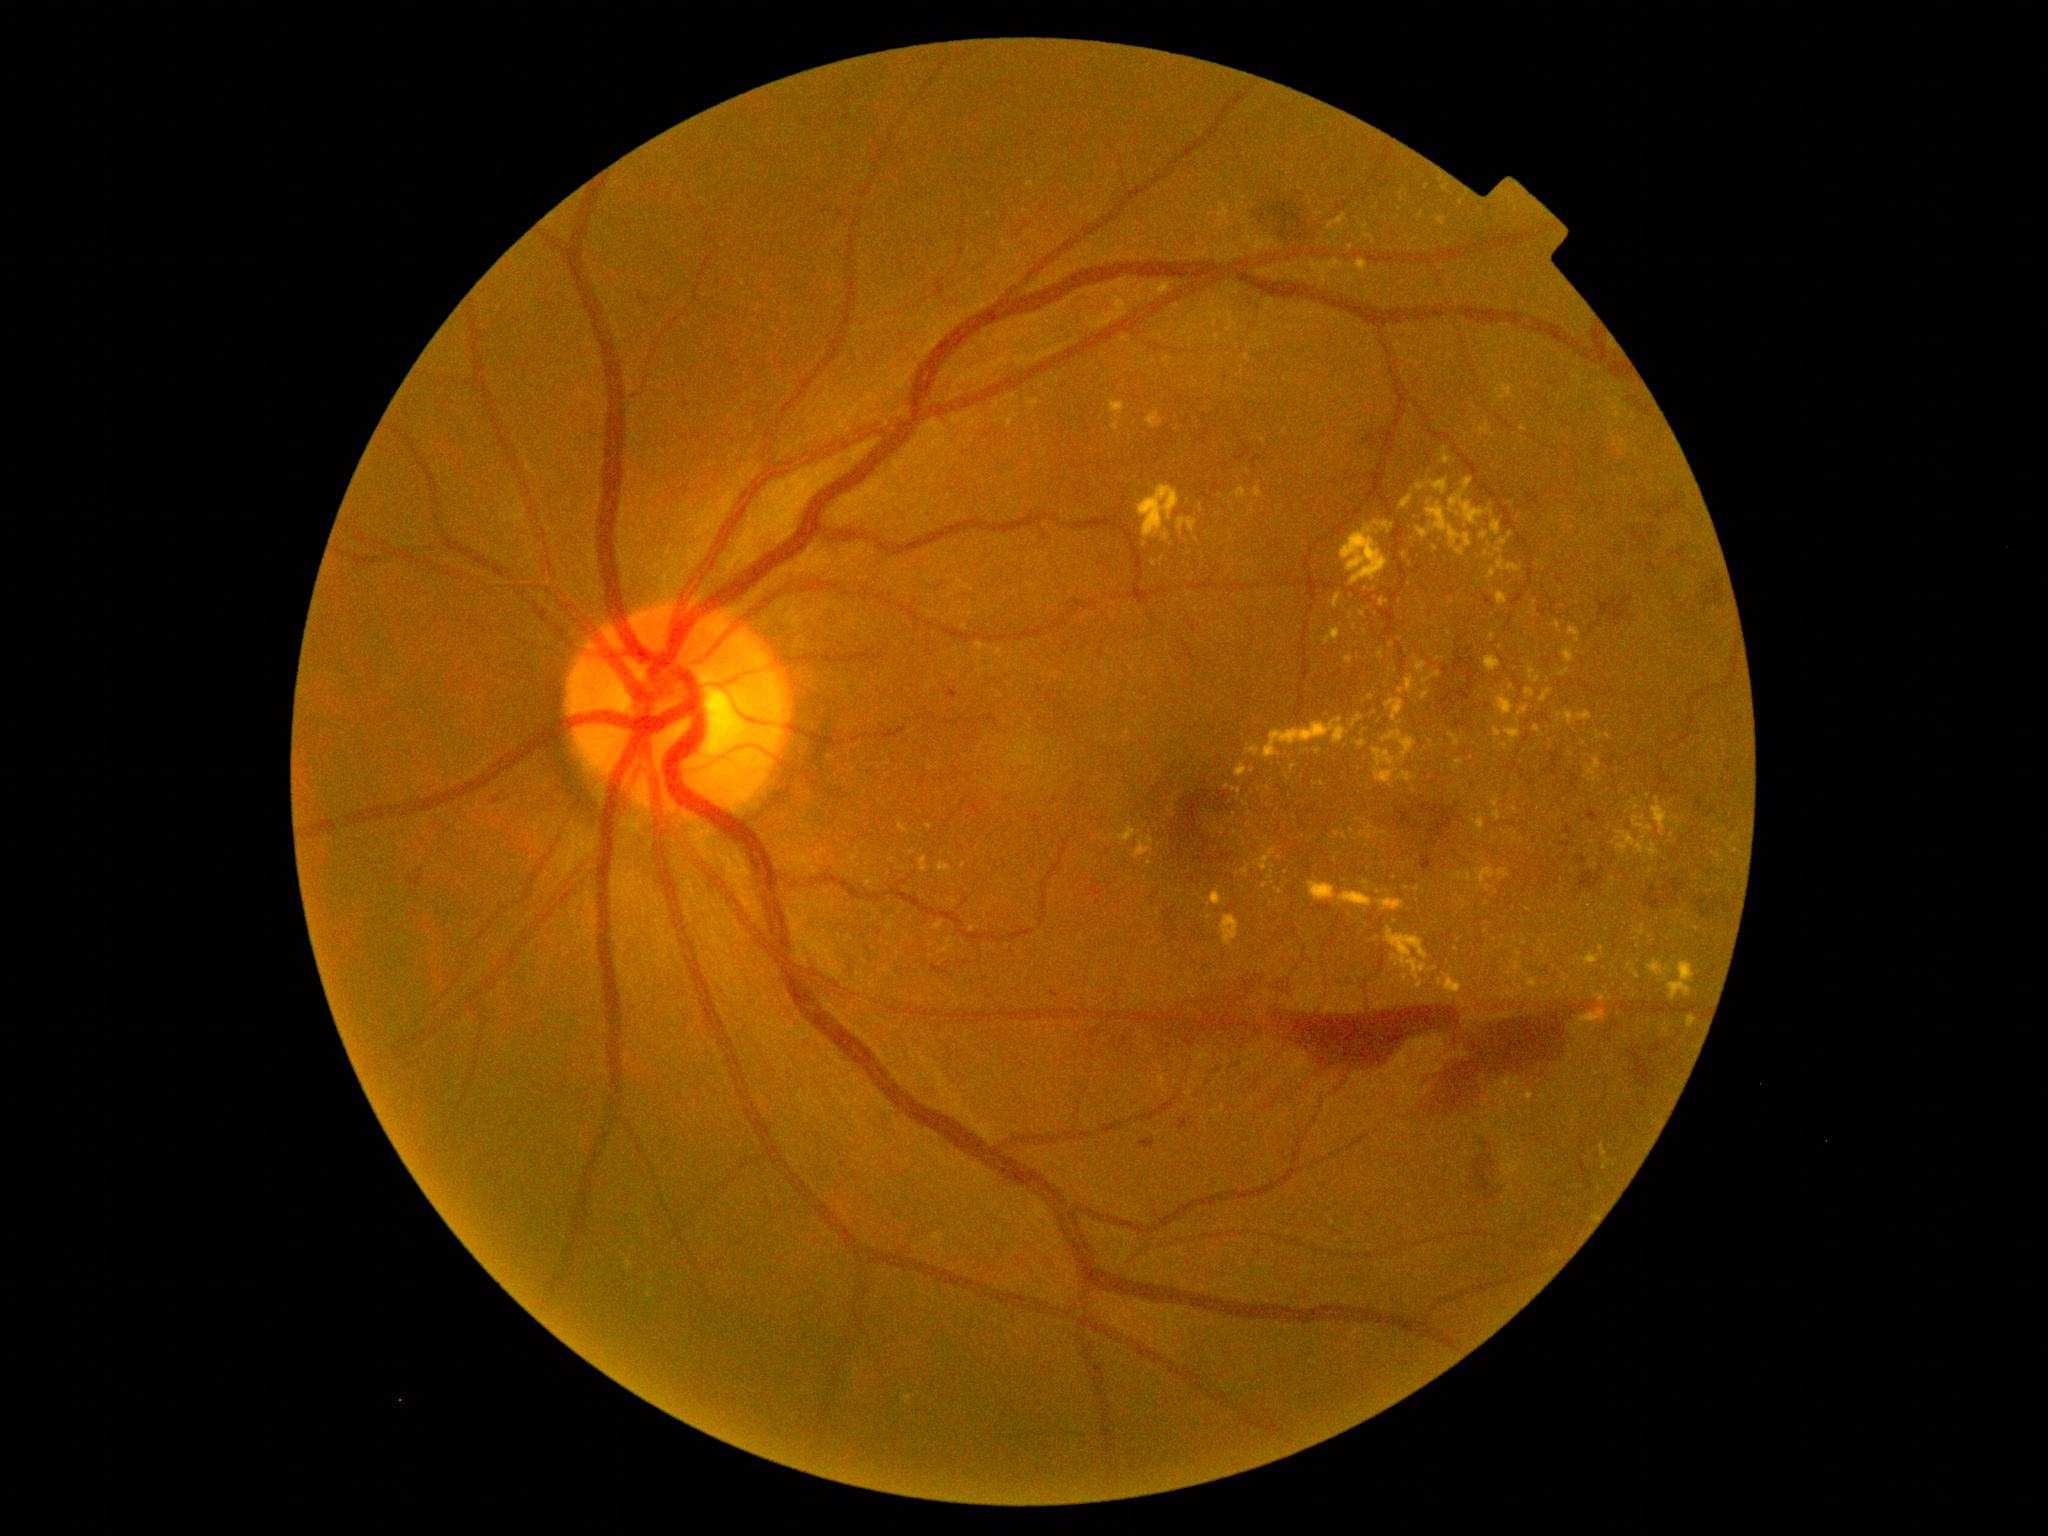
DR is 4/4
A subset of detected lesions:
- EXs (partial): 1497 696 1513 716; 1112 422 1119 431; 1423 671 1441 684; 1560 669 1570 677; 1499 869 1510 878; 1340 892 1373 908; 1497 593 1507 606; 1506 729 1522 739
- EXs (small, approximate centers) near Point(1518, 721); Point(1614, 880); Point(1600, 737); Point(1642, 934); Point(1496, 804); Point(1144, 545); Point(1216, 324); Point(1435, 549); Point(1519, 986); Point(1366, 227)